Pediatric wide-field fundus photograph. Camera: Clarity RetCam 3 (130° FOV).
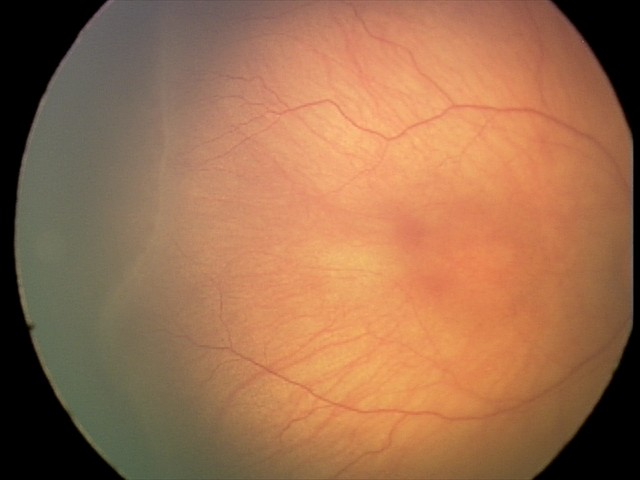

Screening: ROP stage 2 — ridge with height and width at the demarcation line | no plus disease.